FOV: 45 degrees. Color fundus image. Image size 1470x1137
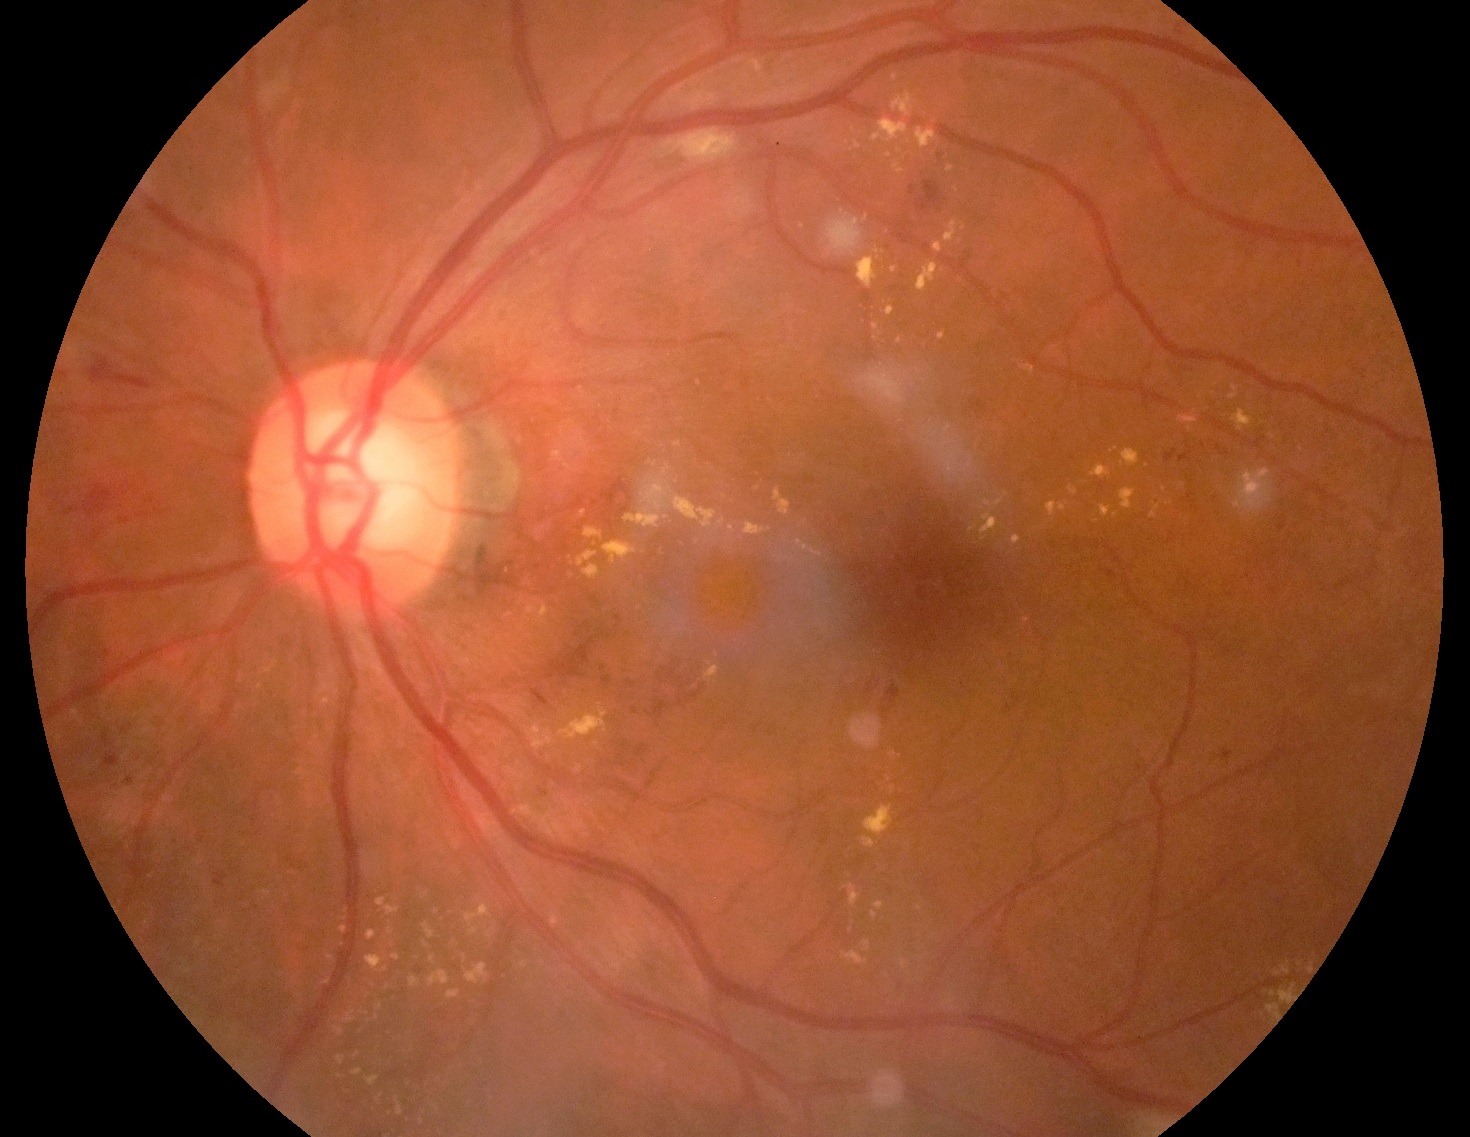 Diabetic retinopathy grade is moderate non-proliferative diabetic retinopathy (2).